240 by 240 pixels; cropped to the optic nerve head:
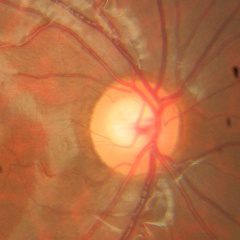

This fundus photograph shows no glaucomatous changes.